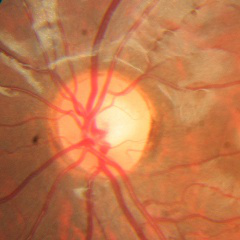
Glaucoma assessment = no glaucomatous changes.